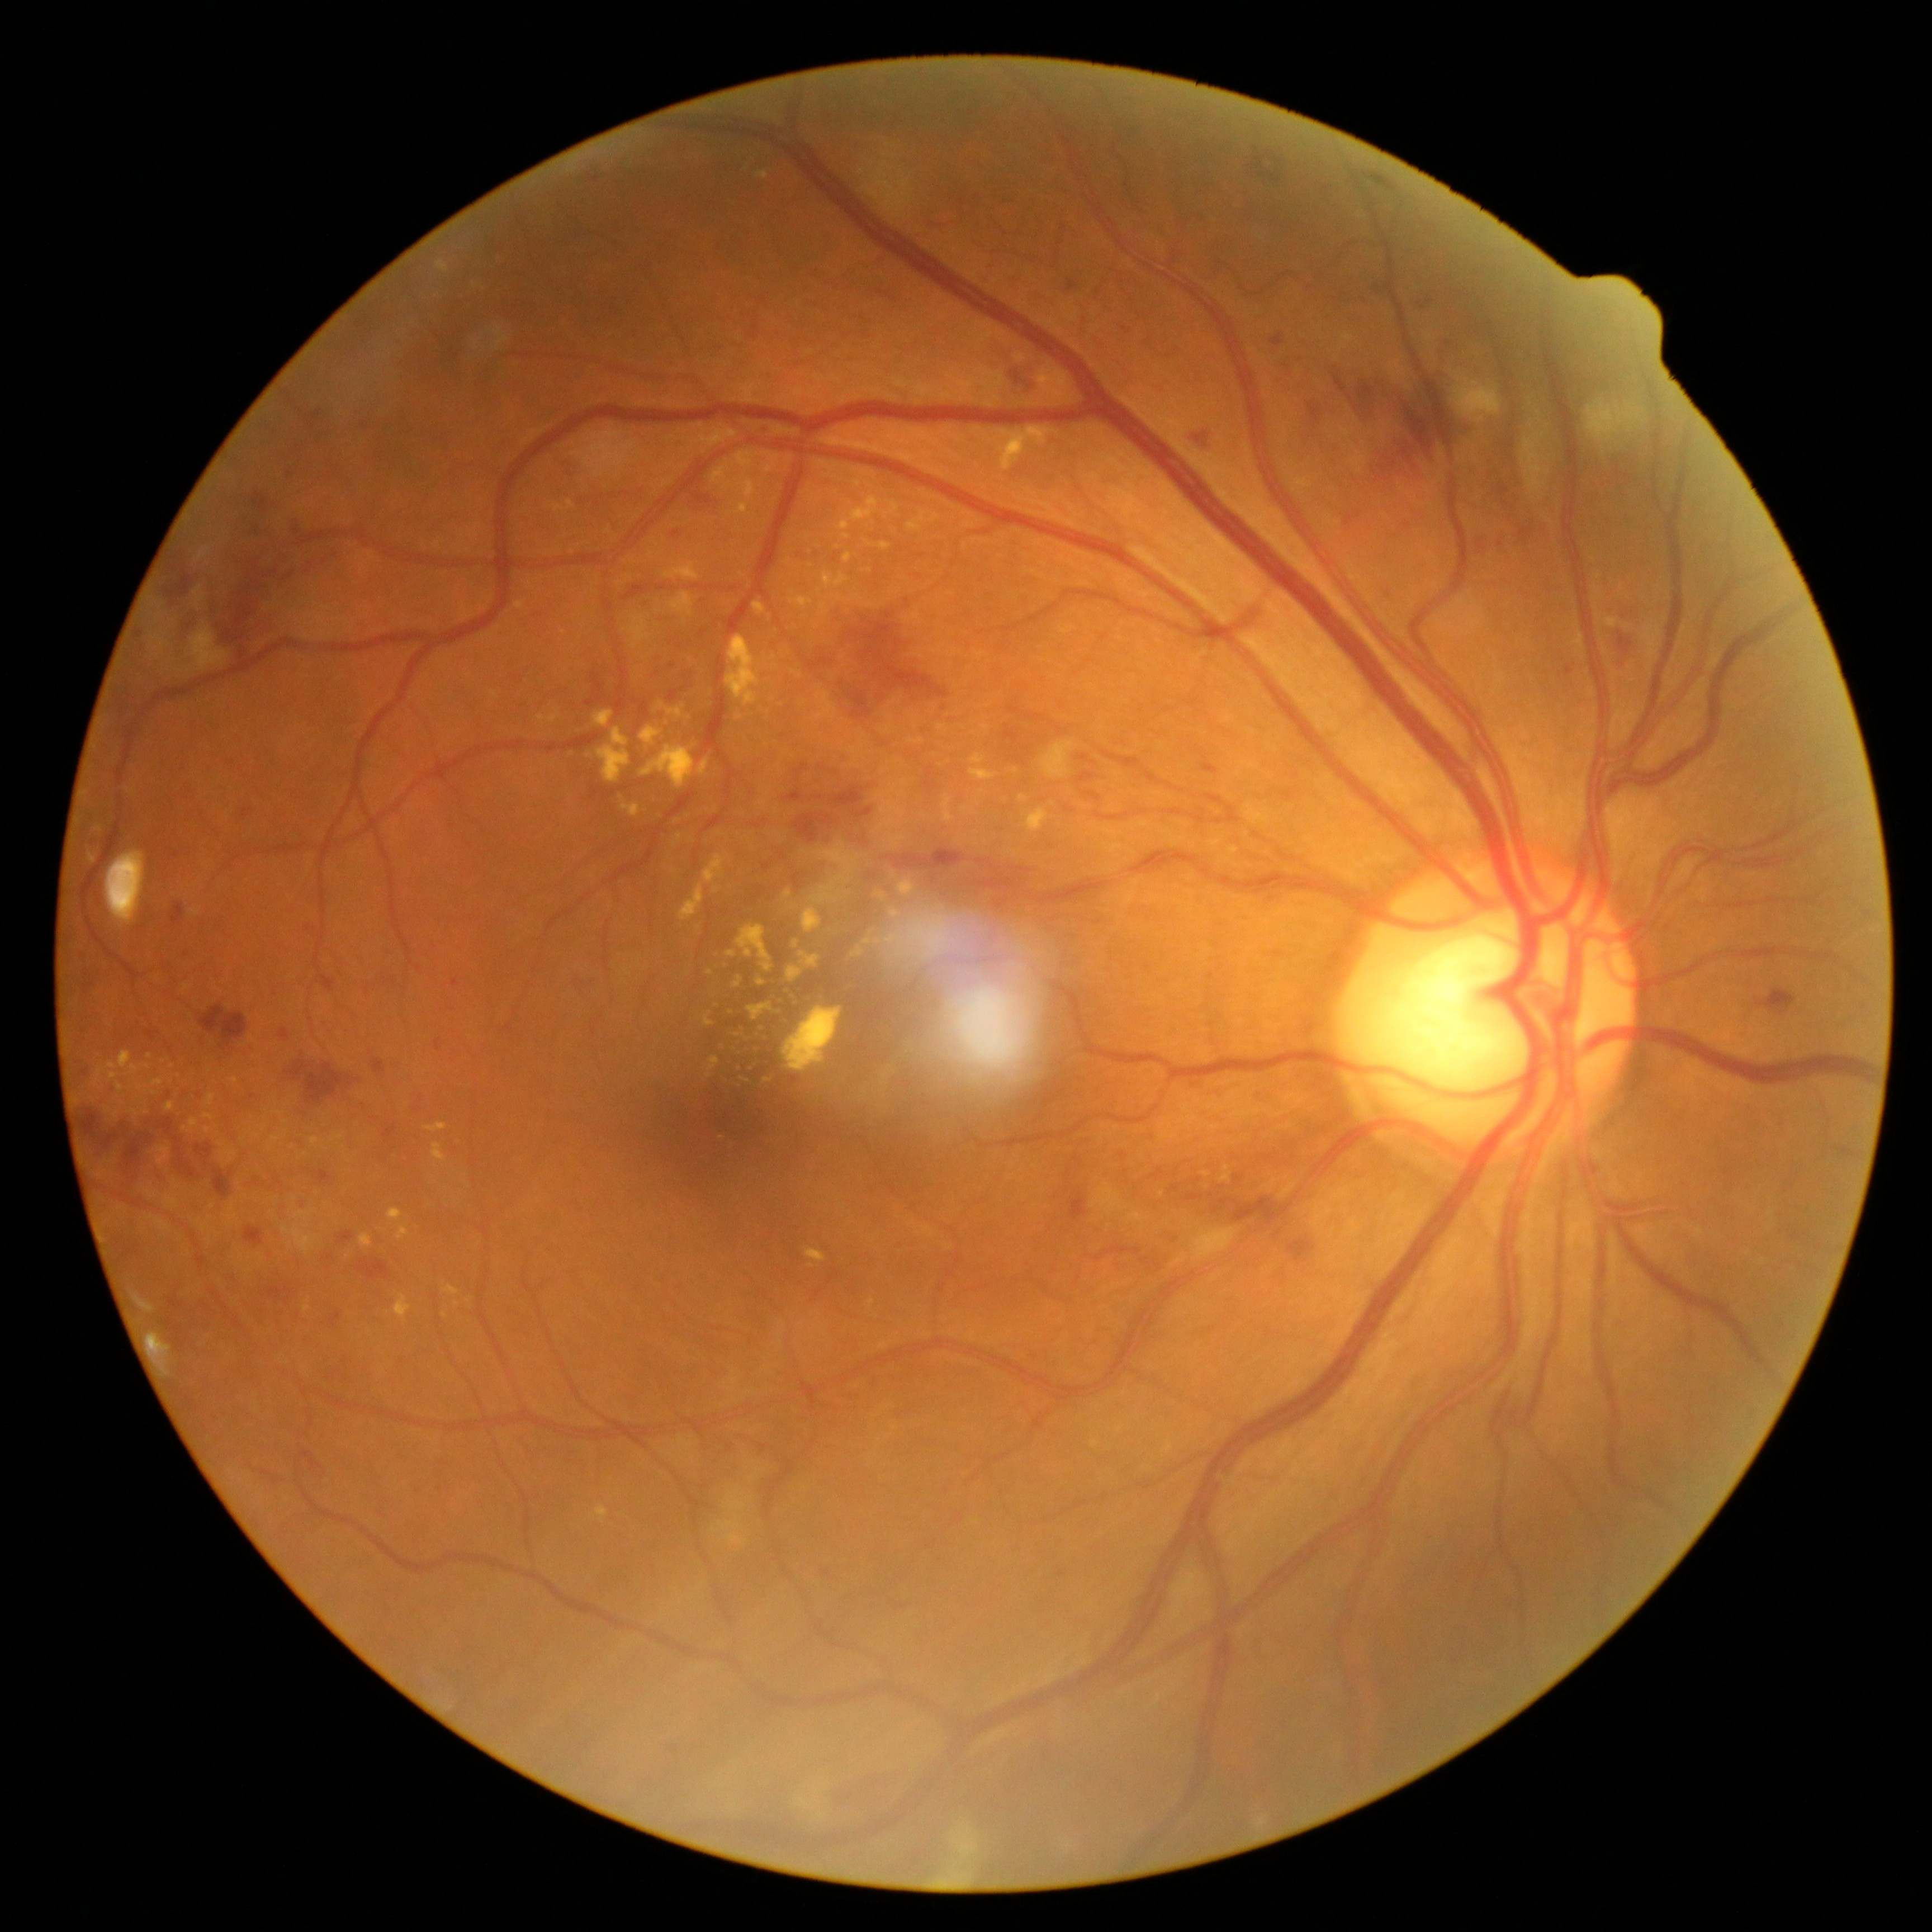
Retinopathy is grade 3 (severe NPDR)
Representative lesions:
- hard exudates (continued): [left=865, top=539, right=893, bottom=551] | [left=908, top=740, right=926, bottom=745] | [left=698, top=761, right=708, bottom=778] | [left=96, top=1053, right=151, bottom=1085] | [left=899, top=879, right=914, bottom=896] | [left=657, top=702, right=686, bottom=719] | [left=673, top=835, right=684, bottom=846] | [left=844, top=552, right=855, bottom=565] | [left=272, top=1137, right=281, bottom=1145] | [left=782, top=1007, right=841, bottom=1074] | [left=727, top=952, right=737, bottom=959] | [left=865, top=525, right=873, bottom=531] | [left=148, top=1054, right=153, bottom=1062]
- Additional small hard exudates near x=141, y=1099 | x=773, y=700 | x=572, y=756 | x=747, y=1041 | x=763, y=1028
- microaneurysms (continued): [left=135, top=631, right=144, bottom=639] | [left=1567, top=667, right=1571, bottom=677] | [left=586, top=699, right=598, bottom=707] | [left=755, top=421, right=766, bottom=433] | [left=594, top=673, right=604, bottom=695] | [left=1476, top=542, right=1485, bottom=551] | [left=1426, top=300, right=1434, bottom=305] | [left=279, top=1029, right=290, bottom=1044] | [left=306, top=924, right=314, bottom=932]
- Additional small microaneurysms near x=676, y=534 | x=1377, y=289
- hemorrhages (continued): [left=1198, top=429, right=1213, bottom=448] | [left=1071, top=1195, right=1086, bottom=1221] | [left=669, top=671, right=693, bottom=705] | [left=1011, top=867, right=1035, bottom=874] | [left=374, top=1059, right=385, bottom=1074] | [left=297, top=1447, right=323, bottom=1471] | [left=808, top=607, right=953, bottom=717] | [left=1499, top=335, right=1520, bottom=498] | [left=1083, top=791, right=1101, bottom=802] | [left=1376, top=447, right=1417, bottom=495] | [left=1079, top=755, right=1090, bottom=763] | [left=1213, top=1198, right=1292, bottom=1227] | [left=1333, top=374, right=1347, bottom=392] | [left=1169, top=1186, right=1180, bottom=1195] | [left=1491, top=1394, right=1511, bottom=1450] | [left=571, top=973, right=593, bottom=989] | [left=356, top=1259, right=391, bottom=1281] | [left=1617, top=631, right=1633, bottom=655]
- Additional small hemorrhages near x=329, y=1258